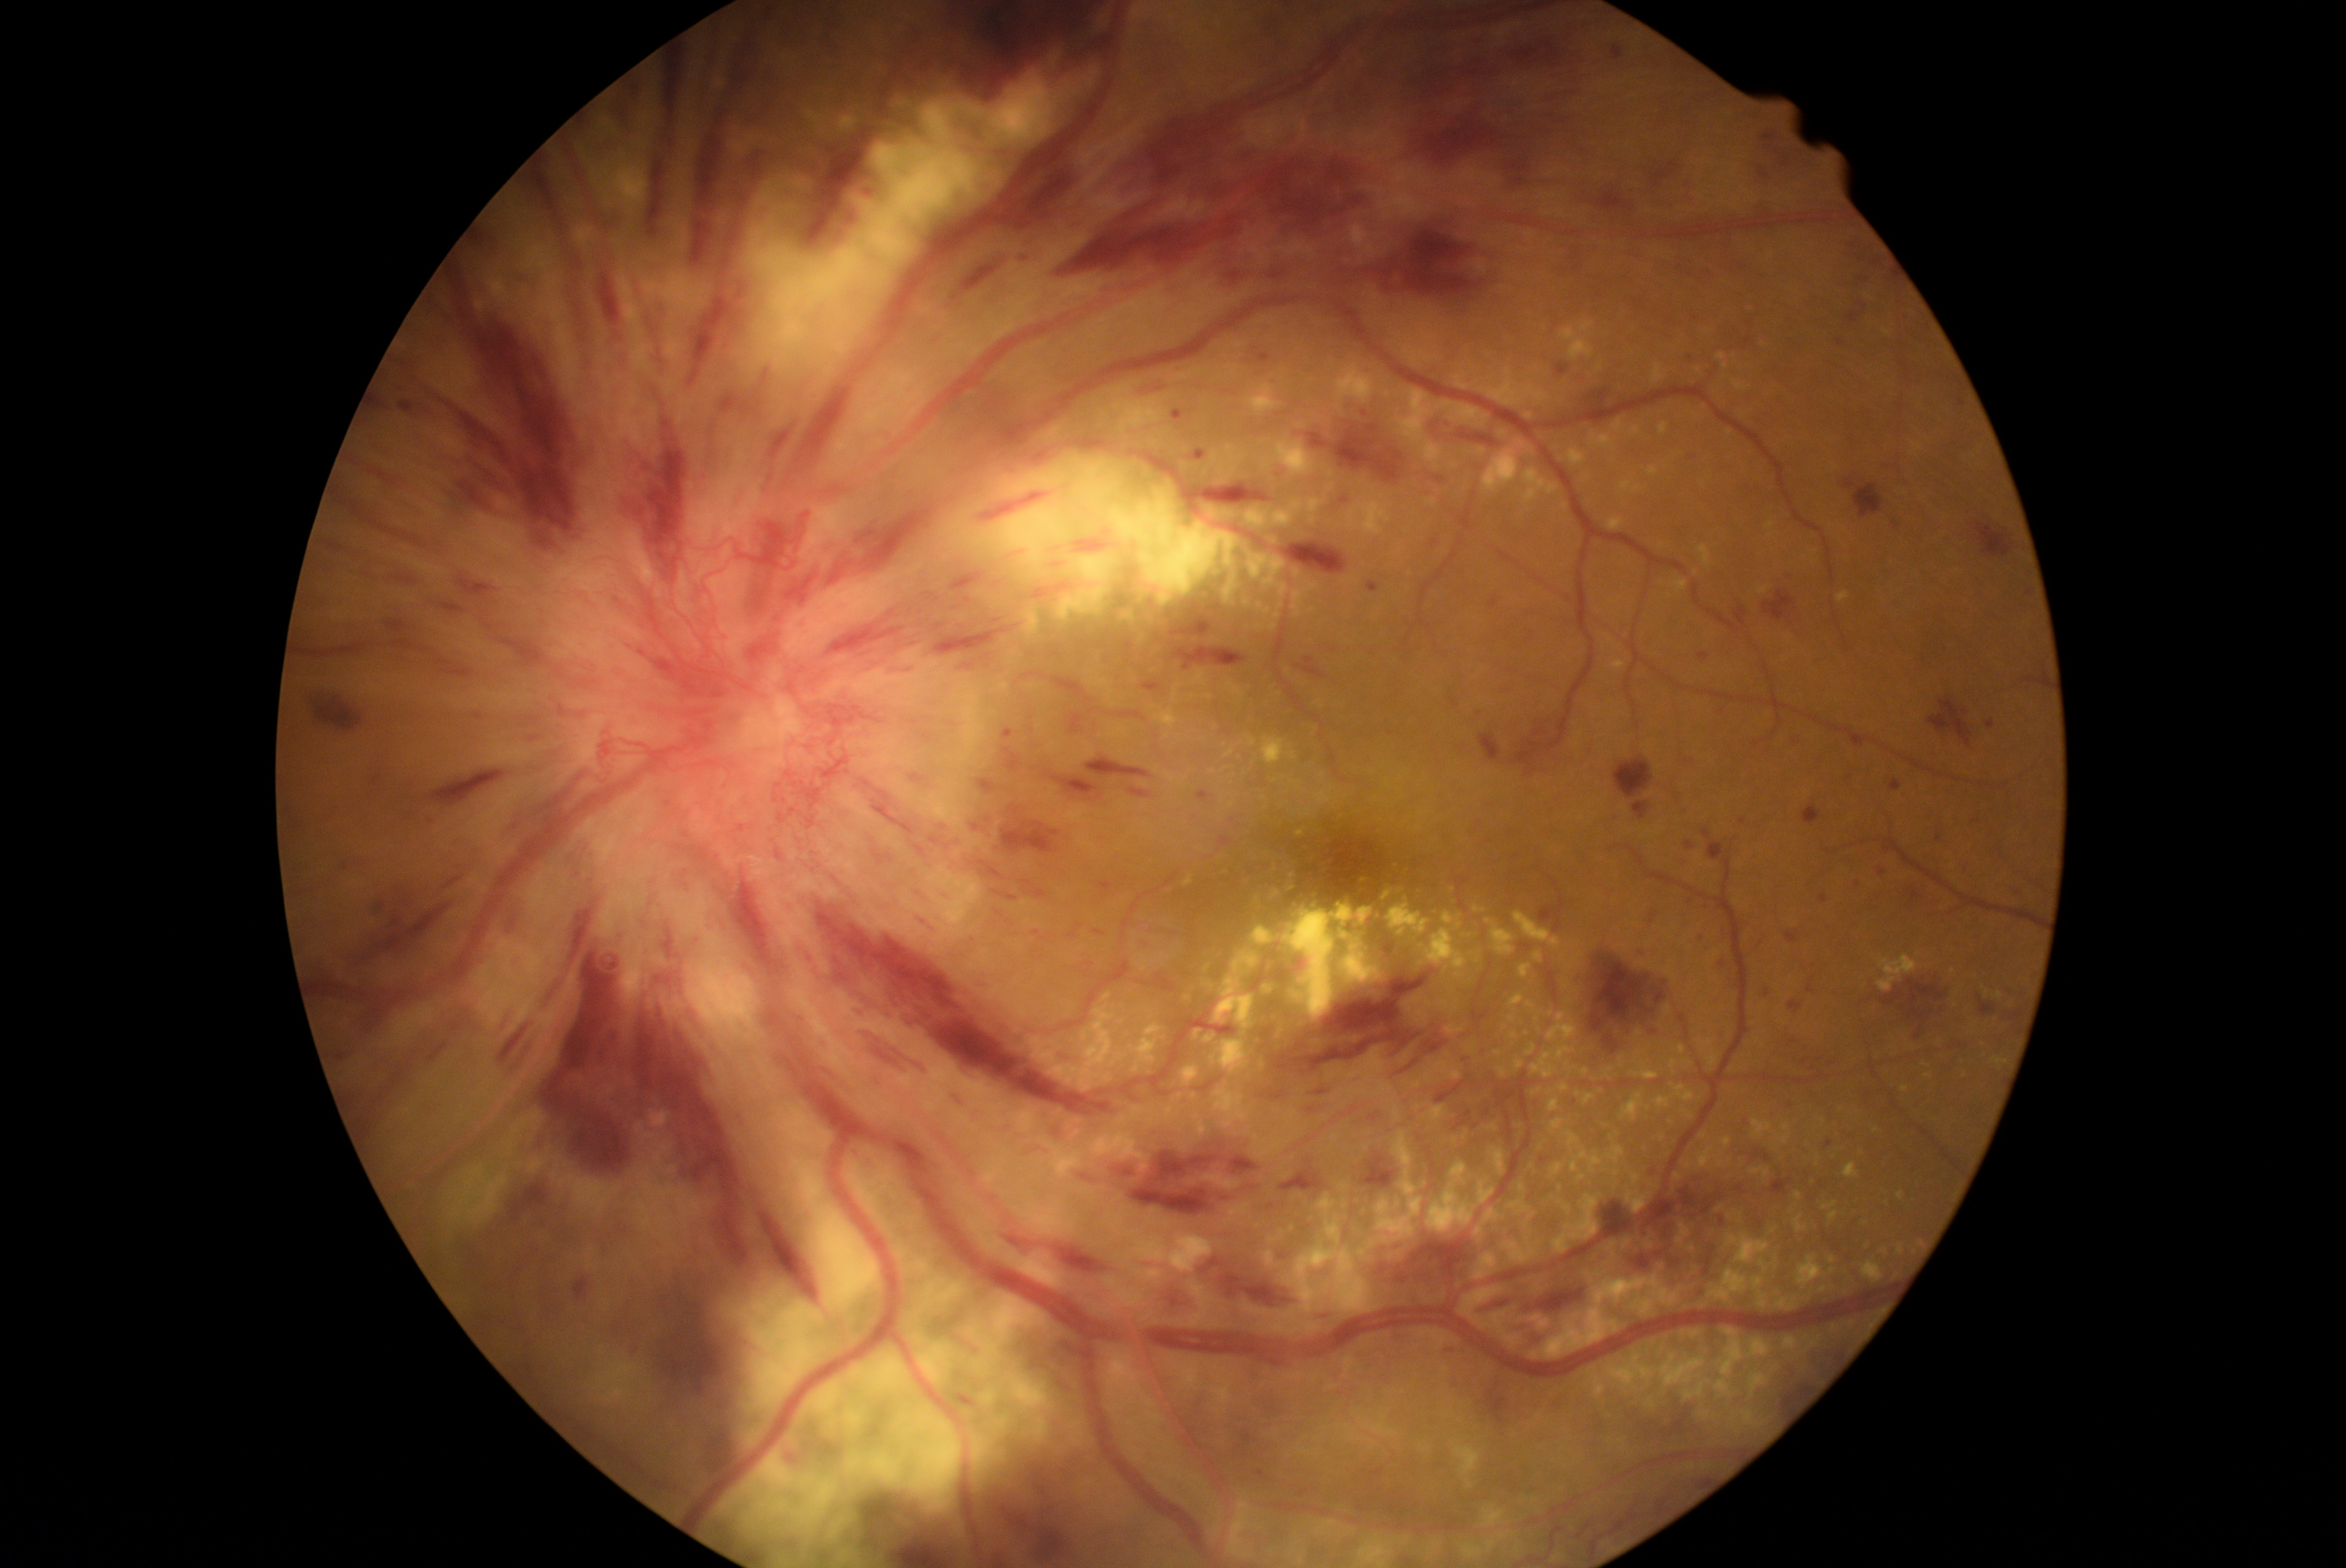

DR severity is 4/4 — neovascularization and/or vitreous/pre-retinal hemorrhage.